Image size 512x512:
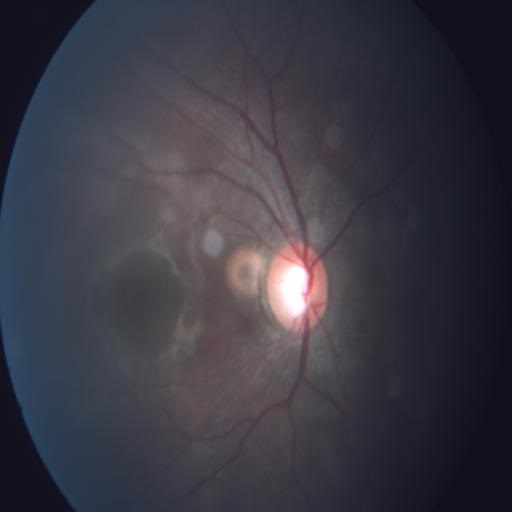 Findings consistent with media haze (MH).